Camera: Clarity RetCam 3 (130° FOV); RetCam wide-field infant fundus image.
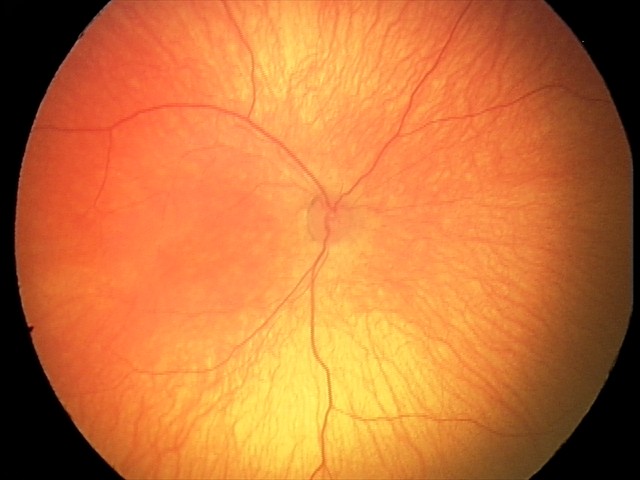 Impression: normal retinal appearance.